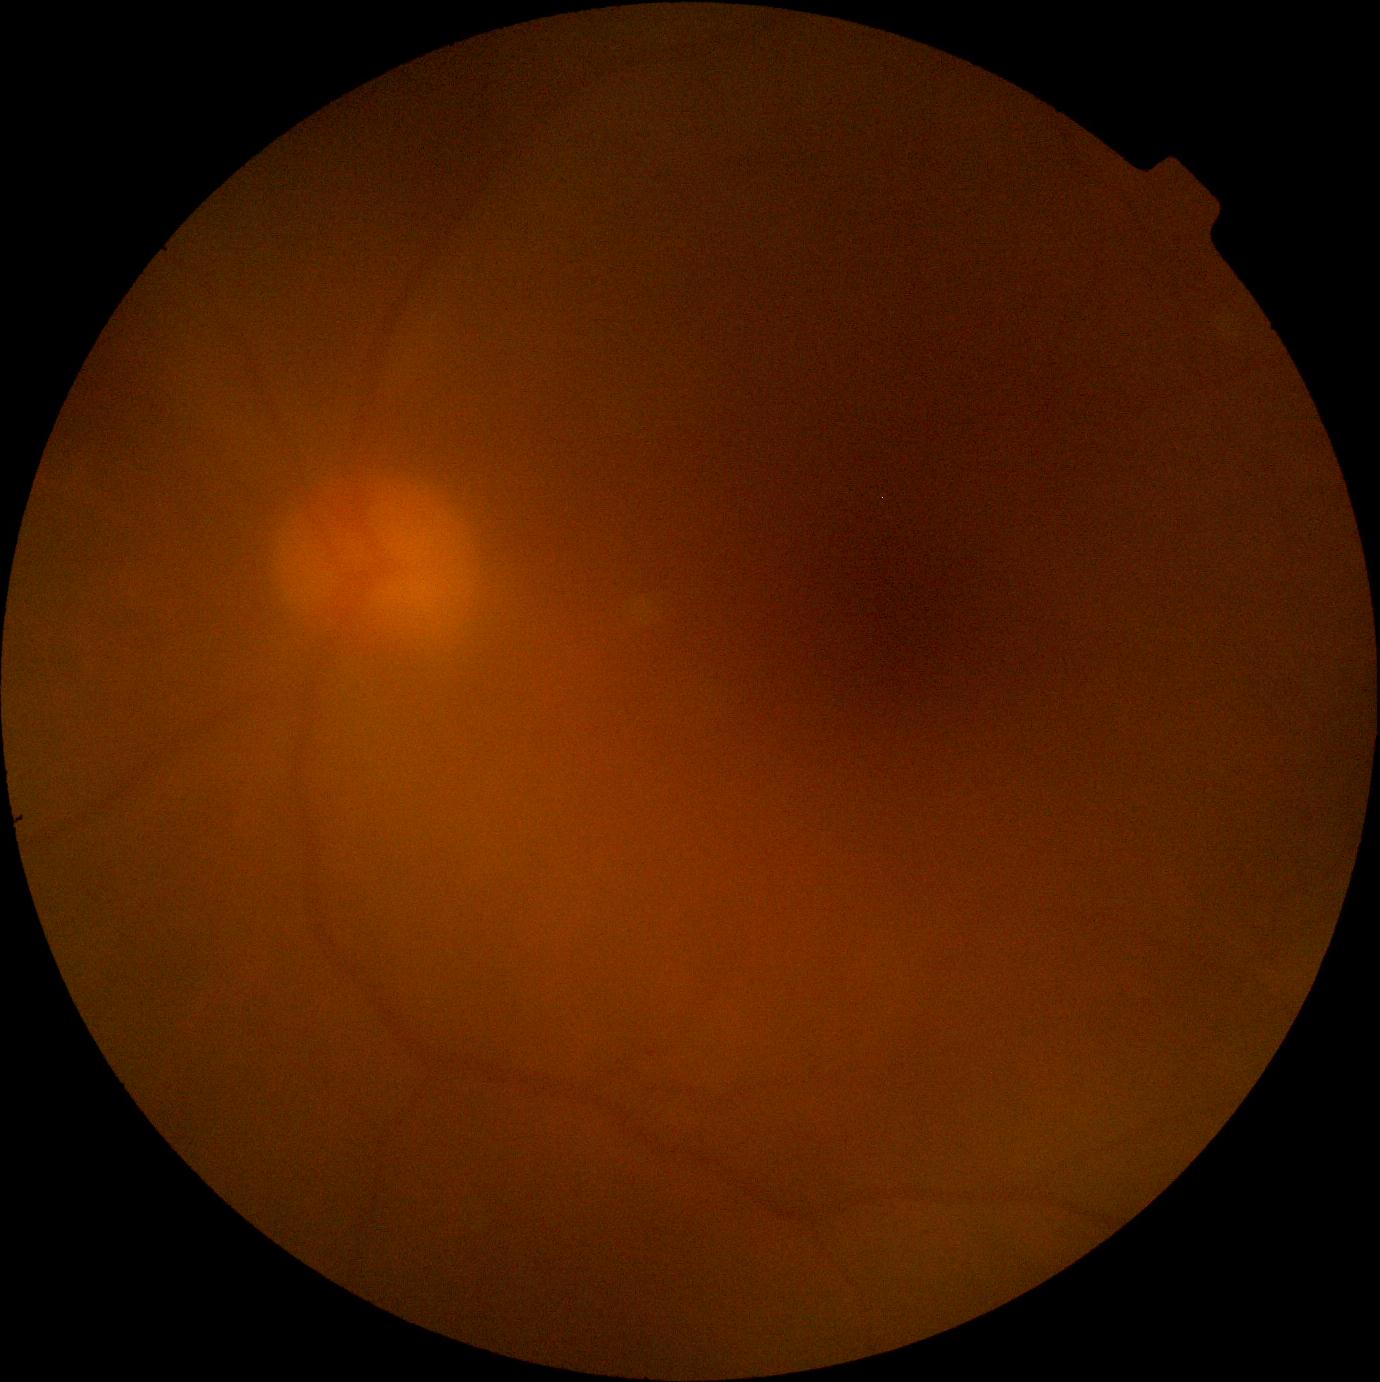

Diabetic retinopathy grade is ungradable due to poor image quality. Ungradable image — DR severity cannot be determined.